Graded on the modified Davis scale: 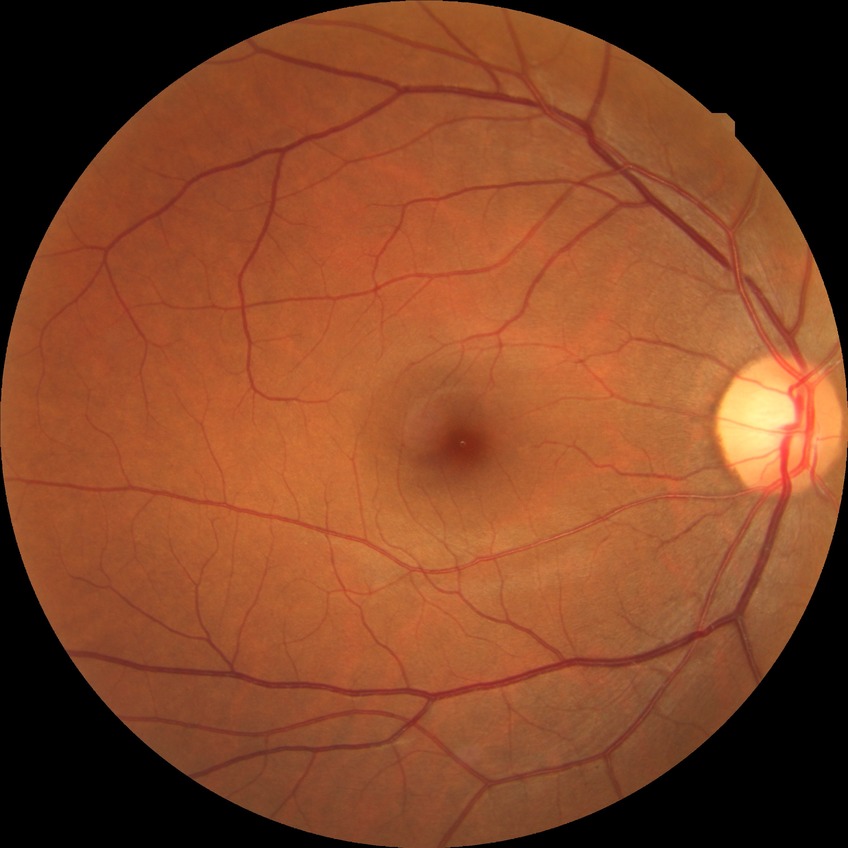 Retinopathy stage: no diabetic retinopathy.